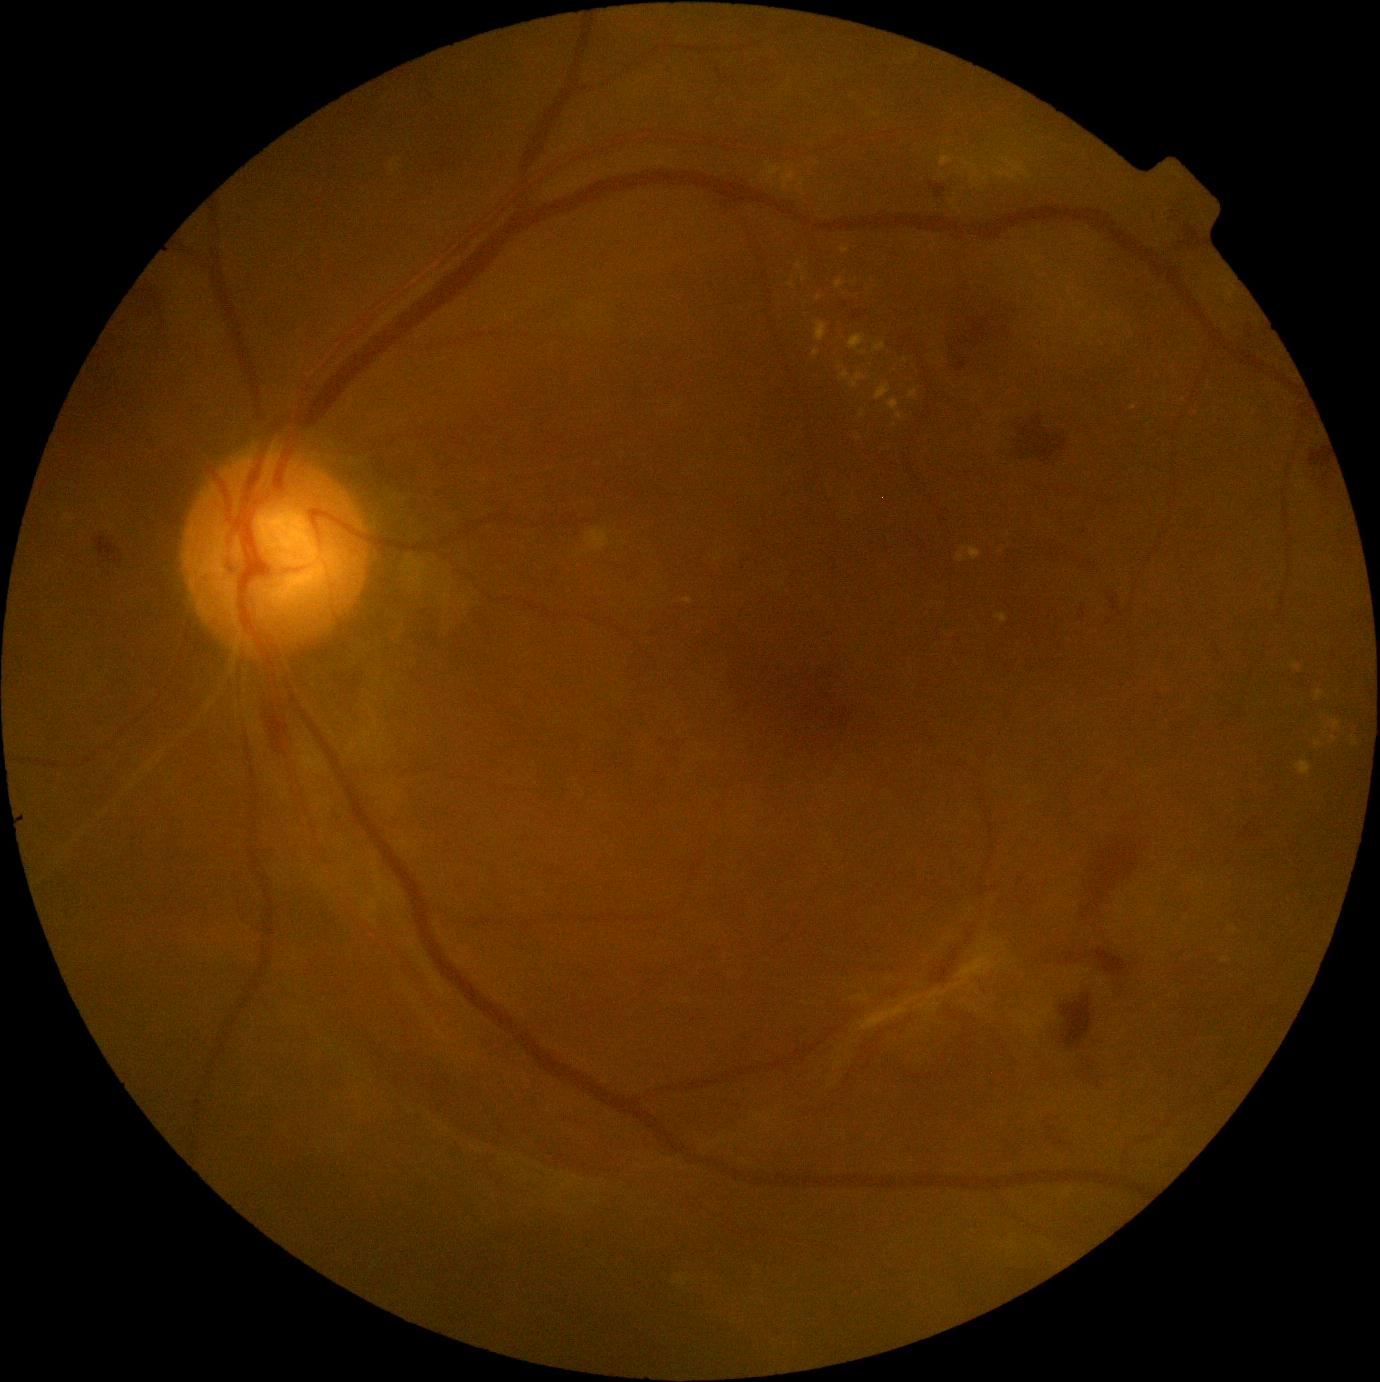
DR stage: grade 4; proliferative diabetic retinopathy
Lesions identified (partial list):
* EXs (more not shown): (816,322,828,342); (1332,721,1341,731); (888,400,899,412); (897,412,903,420); (798,179,805,187); (969,547,981,560); (963,158,981,182); (840,247,849,255); (876,385,890,400); (840,371,851,381)
* EXs (small, approximate centers) near (804, 280); (859, 439); (1355, 743); (819, 299)